Pediatric retinal photograph (wide-field)
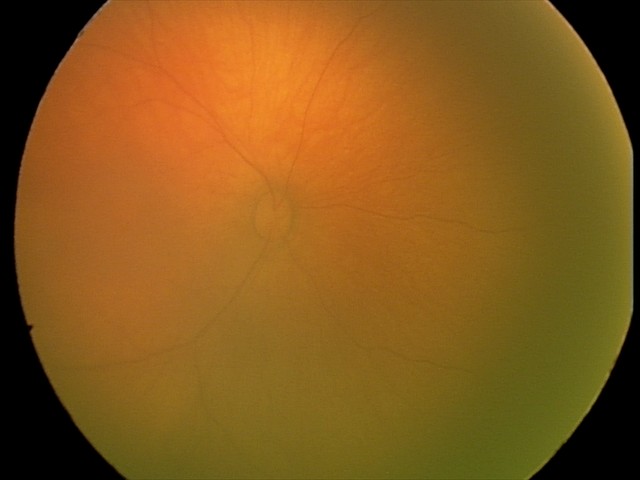 Normal screening examination.